848 x 848 pixels · 45 degree fundus photograph · CFP: 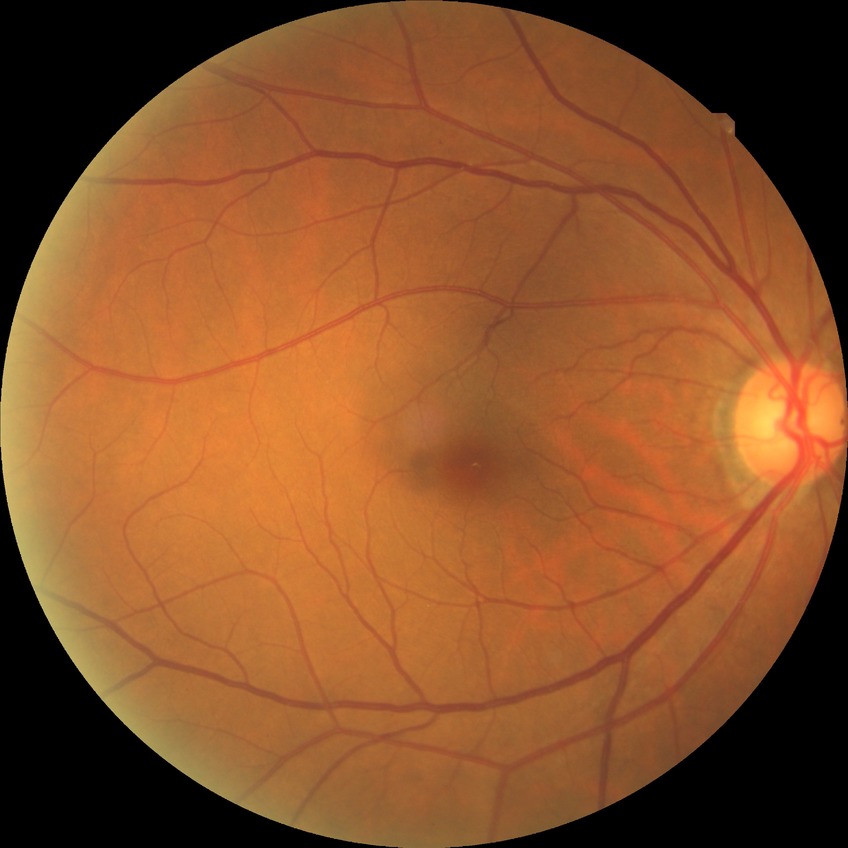 diabetic retinopathy (DR) = NDR (no diabetic retinopathy).